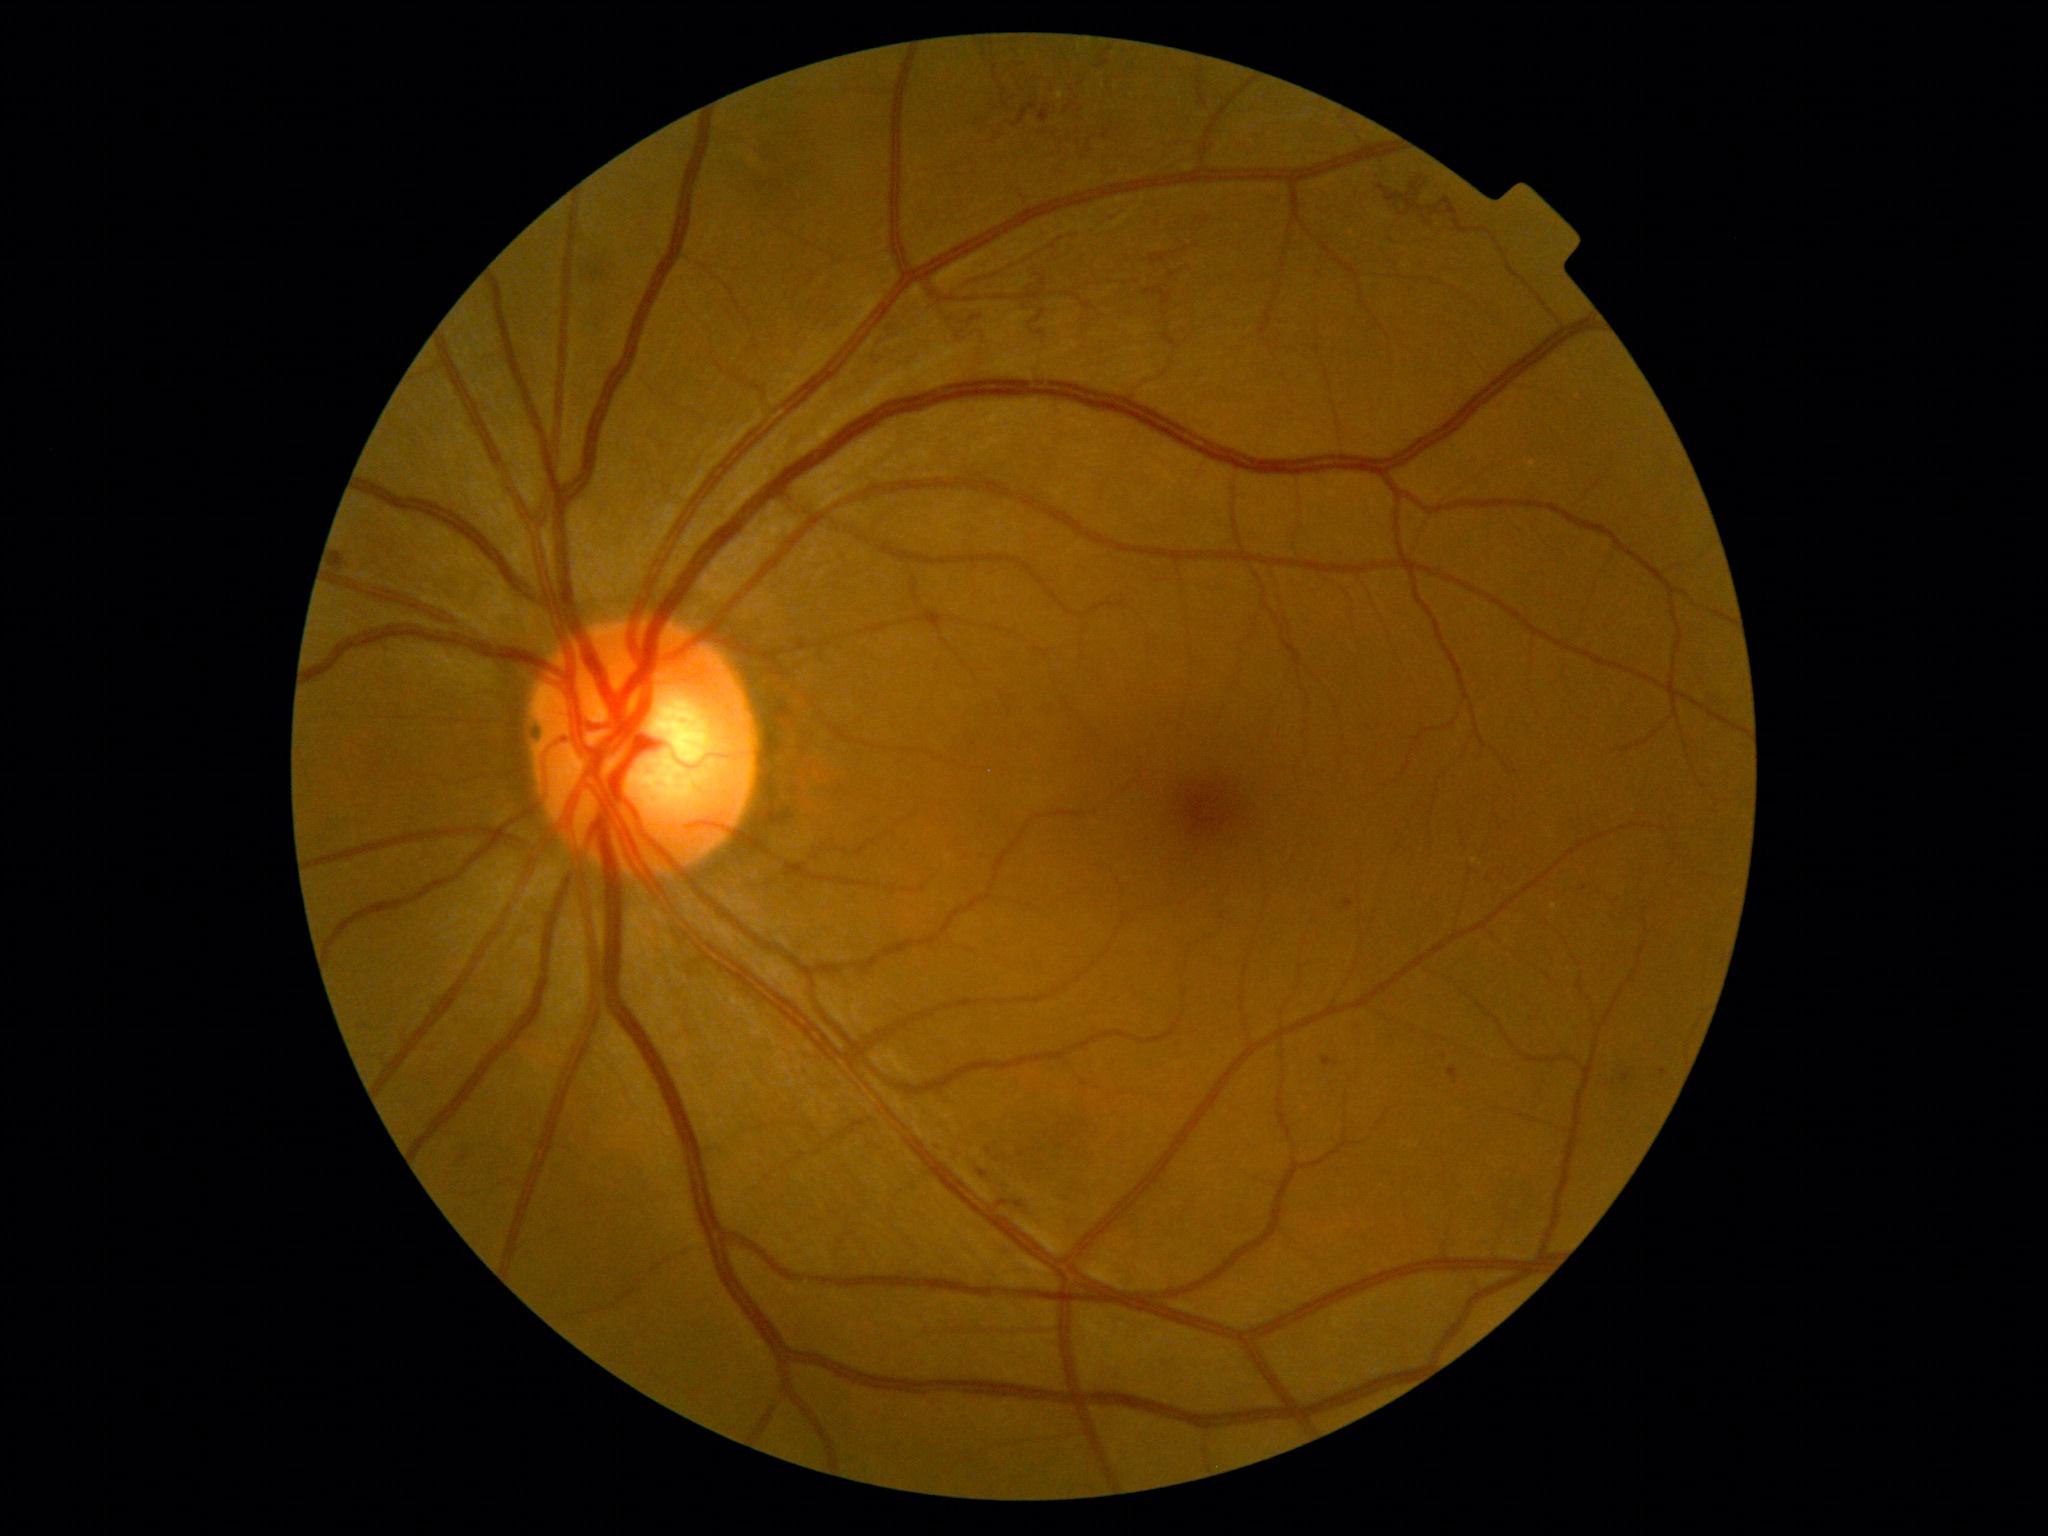

DR severity is grade 3 (severe NPDR).